45° FOV — 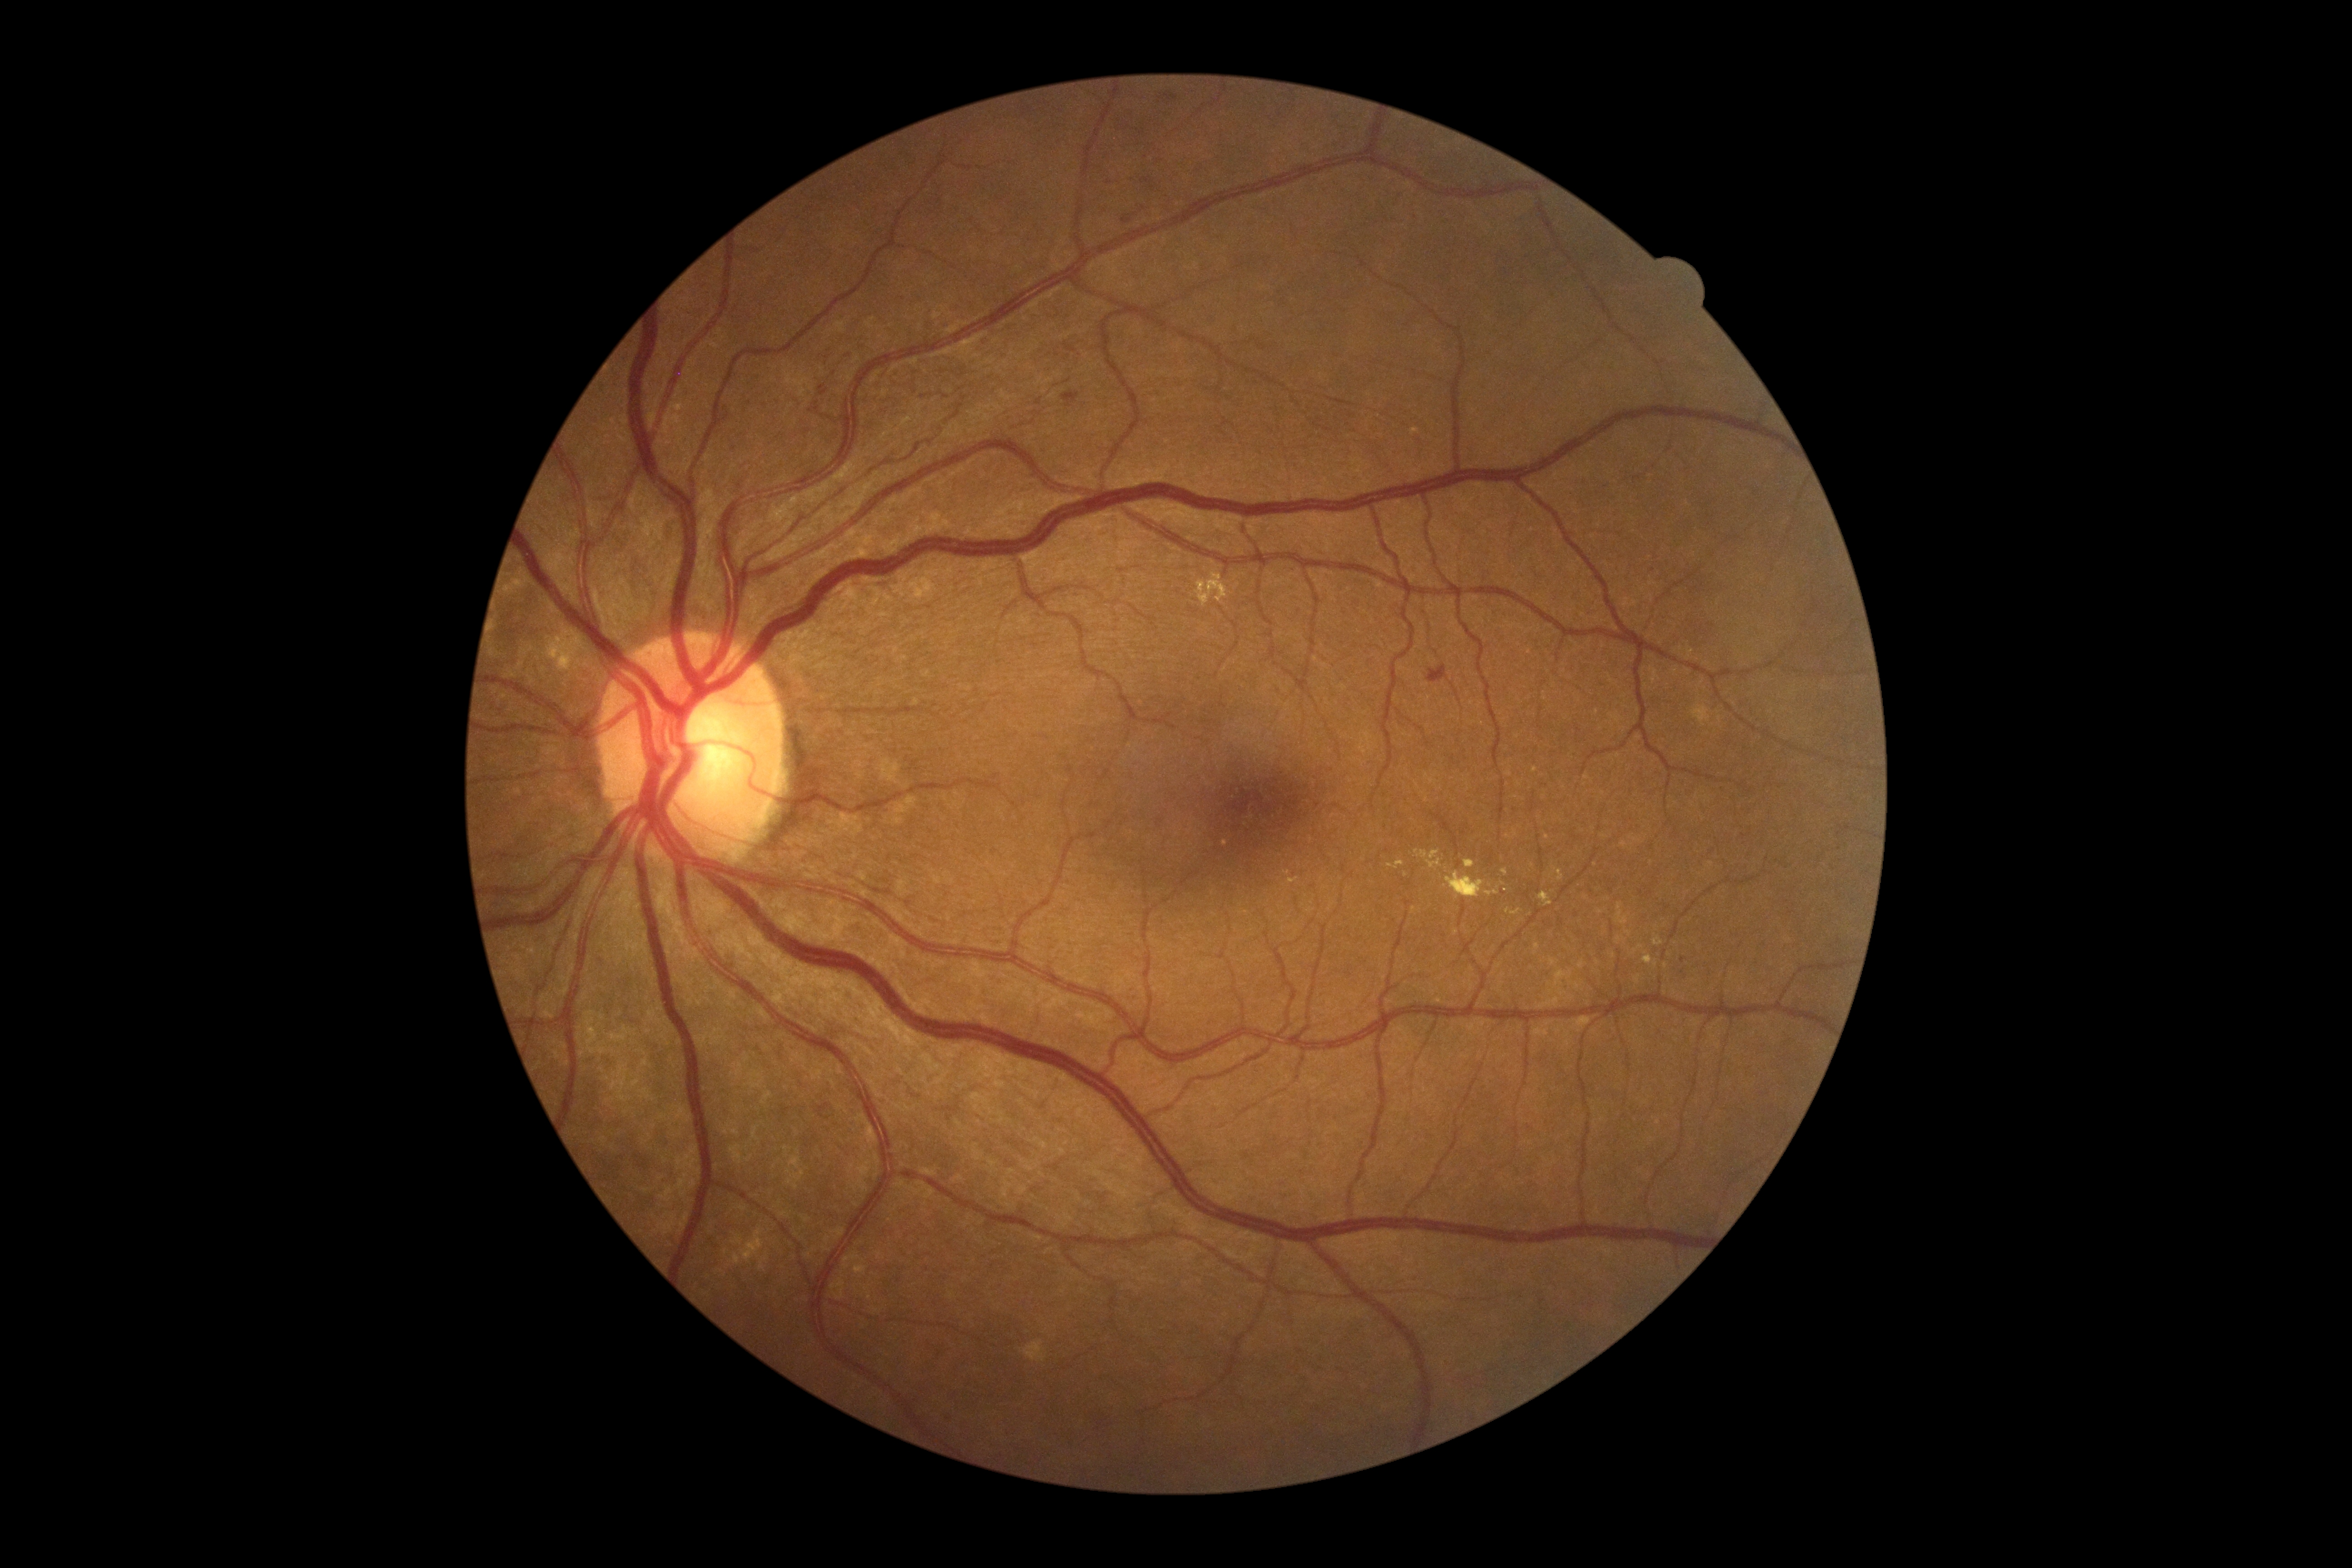

Diabetic retinopathy: 2 — more than just microaneurysms but less than severe NPDR.
No soft exudates identified.
No hemorrhages identified.
Hard exudates (partial list) at [729,1228,770,1272], [1196,570,1228,608], [1415,850,1441,870], [1411,428,1421,436], [1549,867,1563,882], [1510,909,1523,916].
Smaller hard exudates around x=1503, y=884, x=1405, y=874, x=1509, y=837, x=1413, y=910, x=1490, y=885.
Microaneurysms (partial list) at [1061,392,1079,408], [1427,664,1448,684], [1159,91,1178,104], [1123,216,1132,225].
Smaller microaneurysms around x=822, y=388, x=1684, y=960, x=823, y=393.